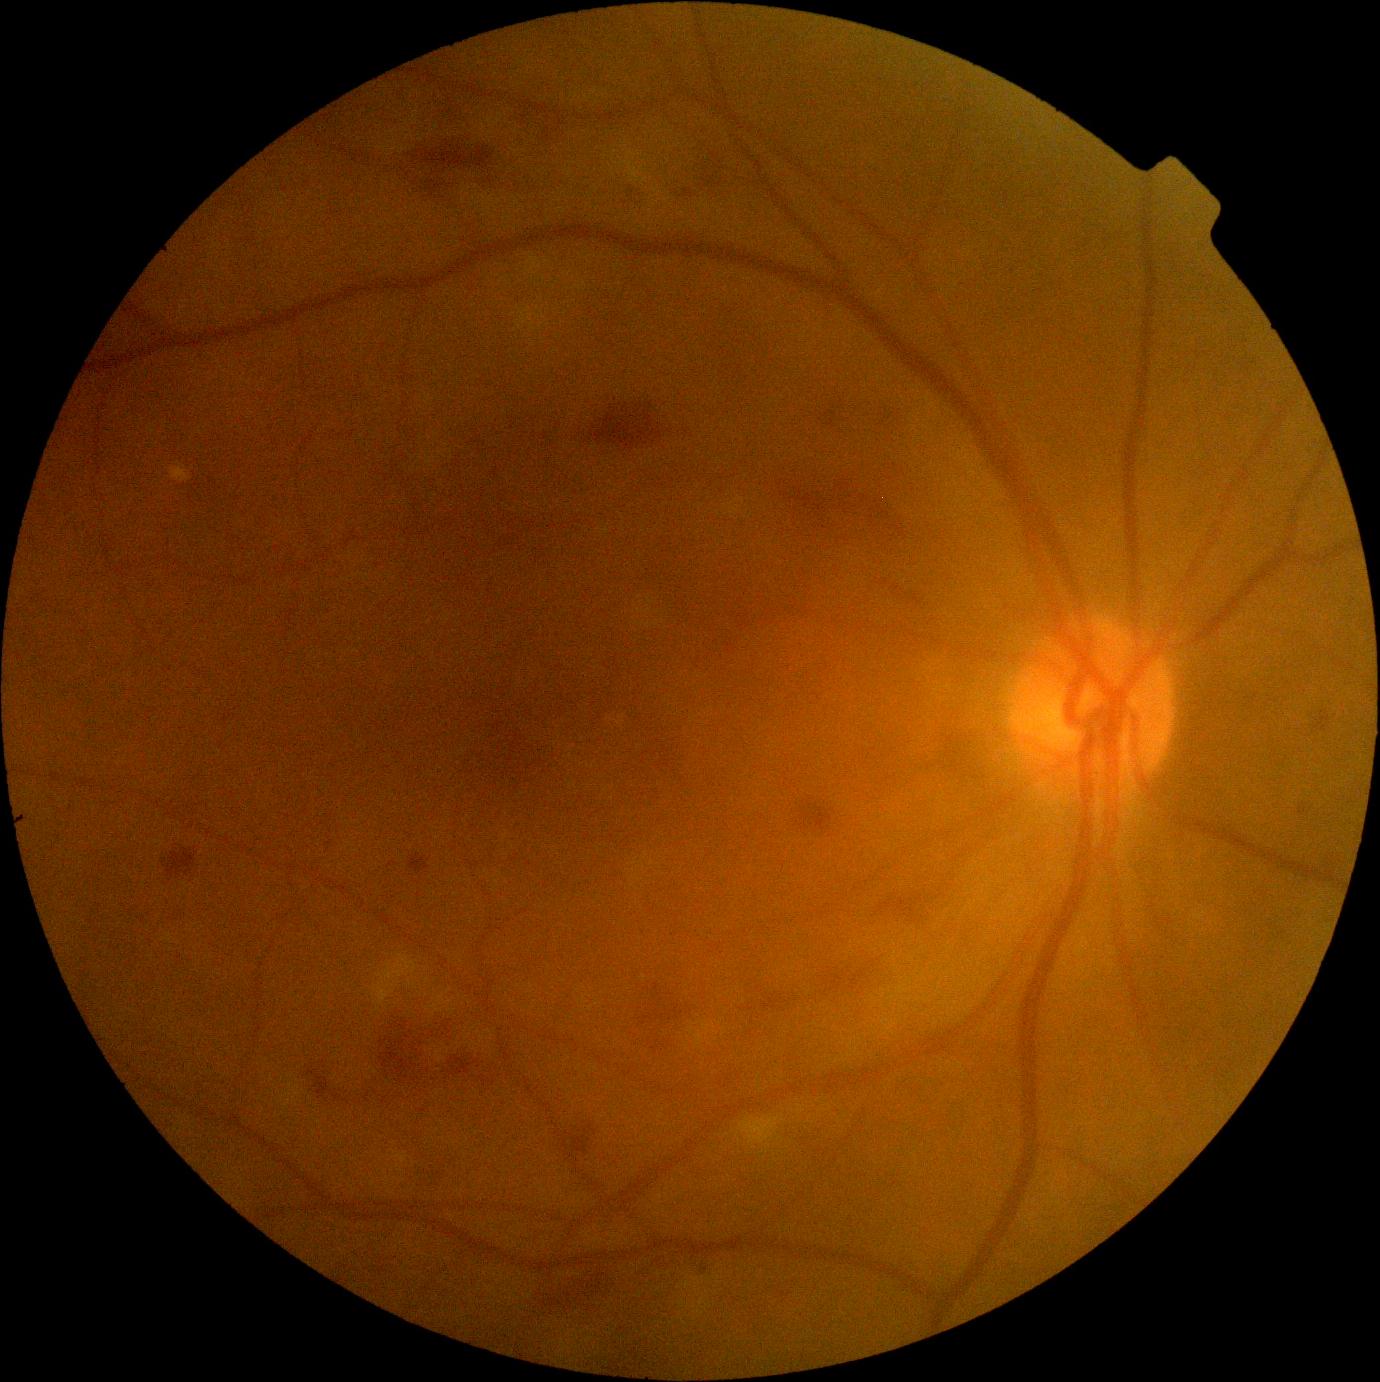 DR stage: moderate non-proliferative diabetic retinopathy (grade 2).